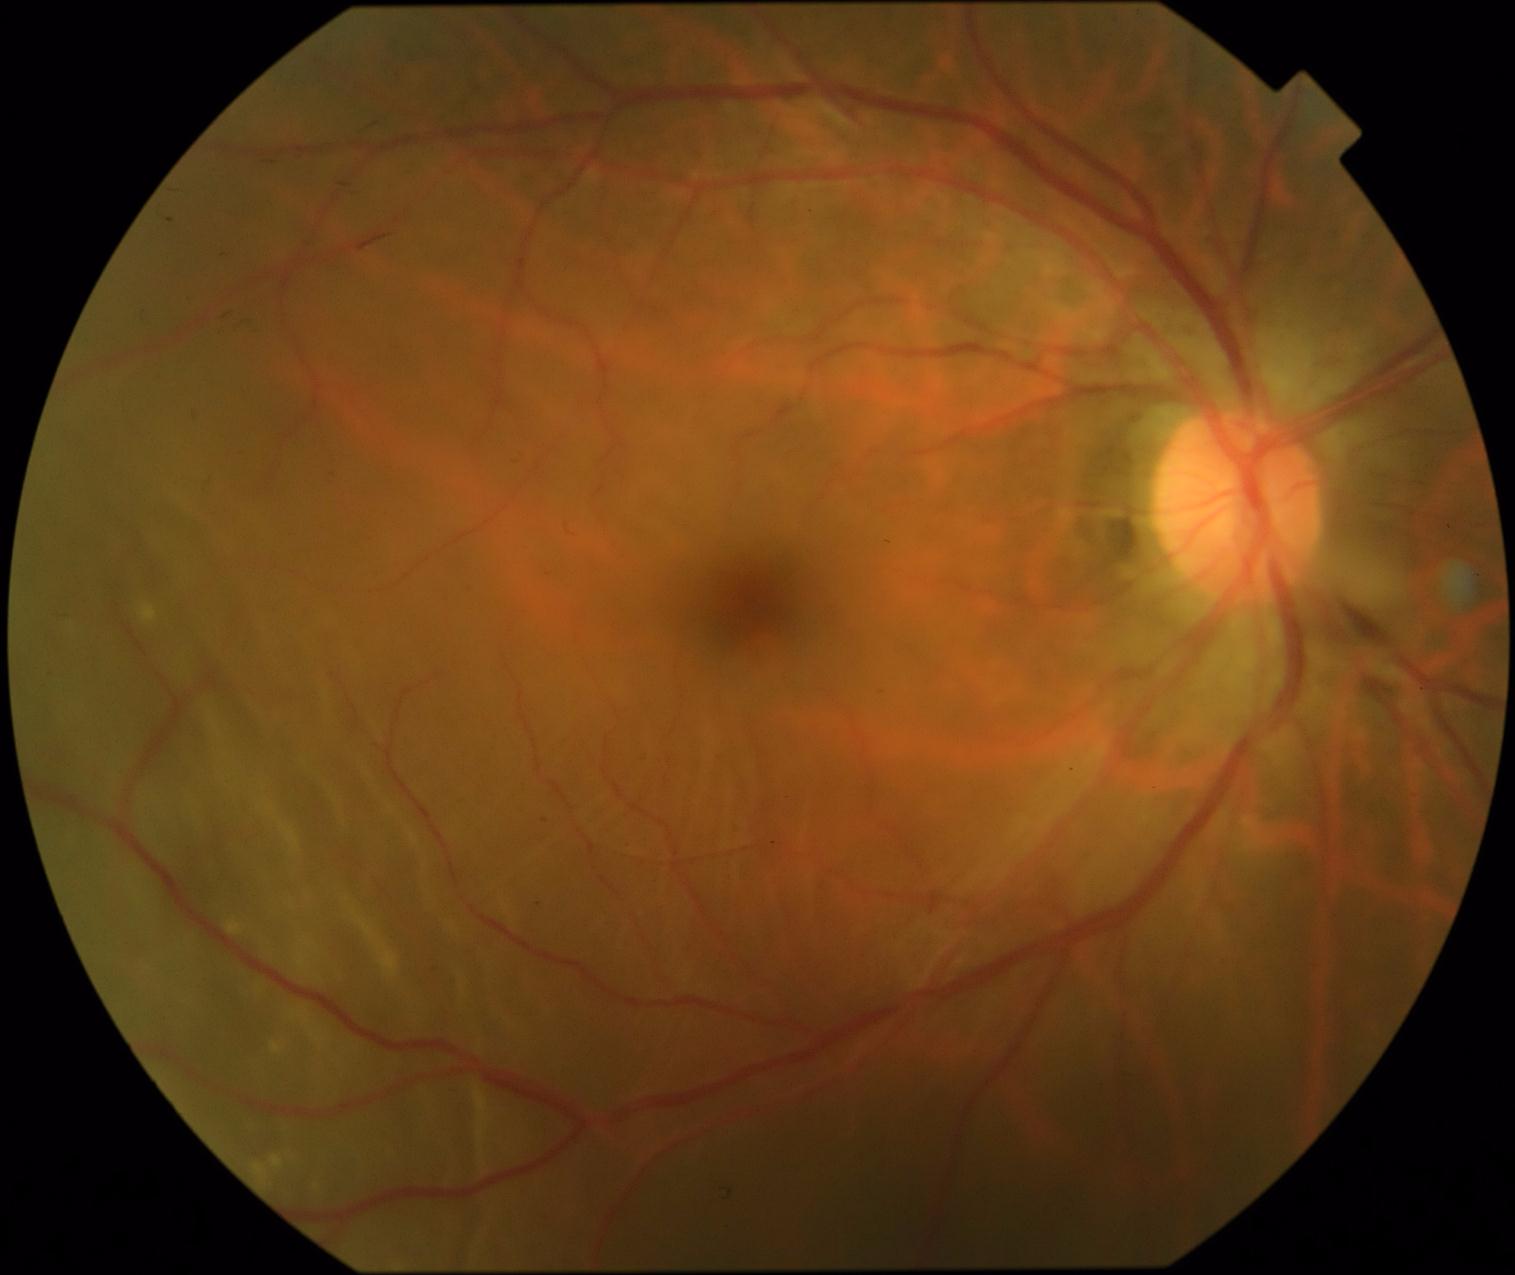

The retinopathy is classified as proliferative diabetic retinopathy. Diabetic retinopathy grade is PDR (4).